Topcon TRC-NW8.
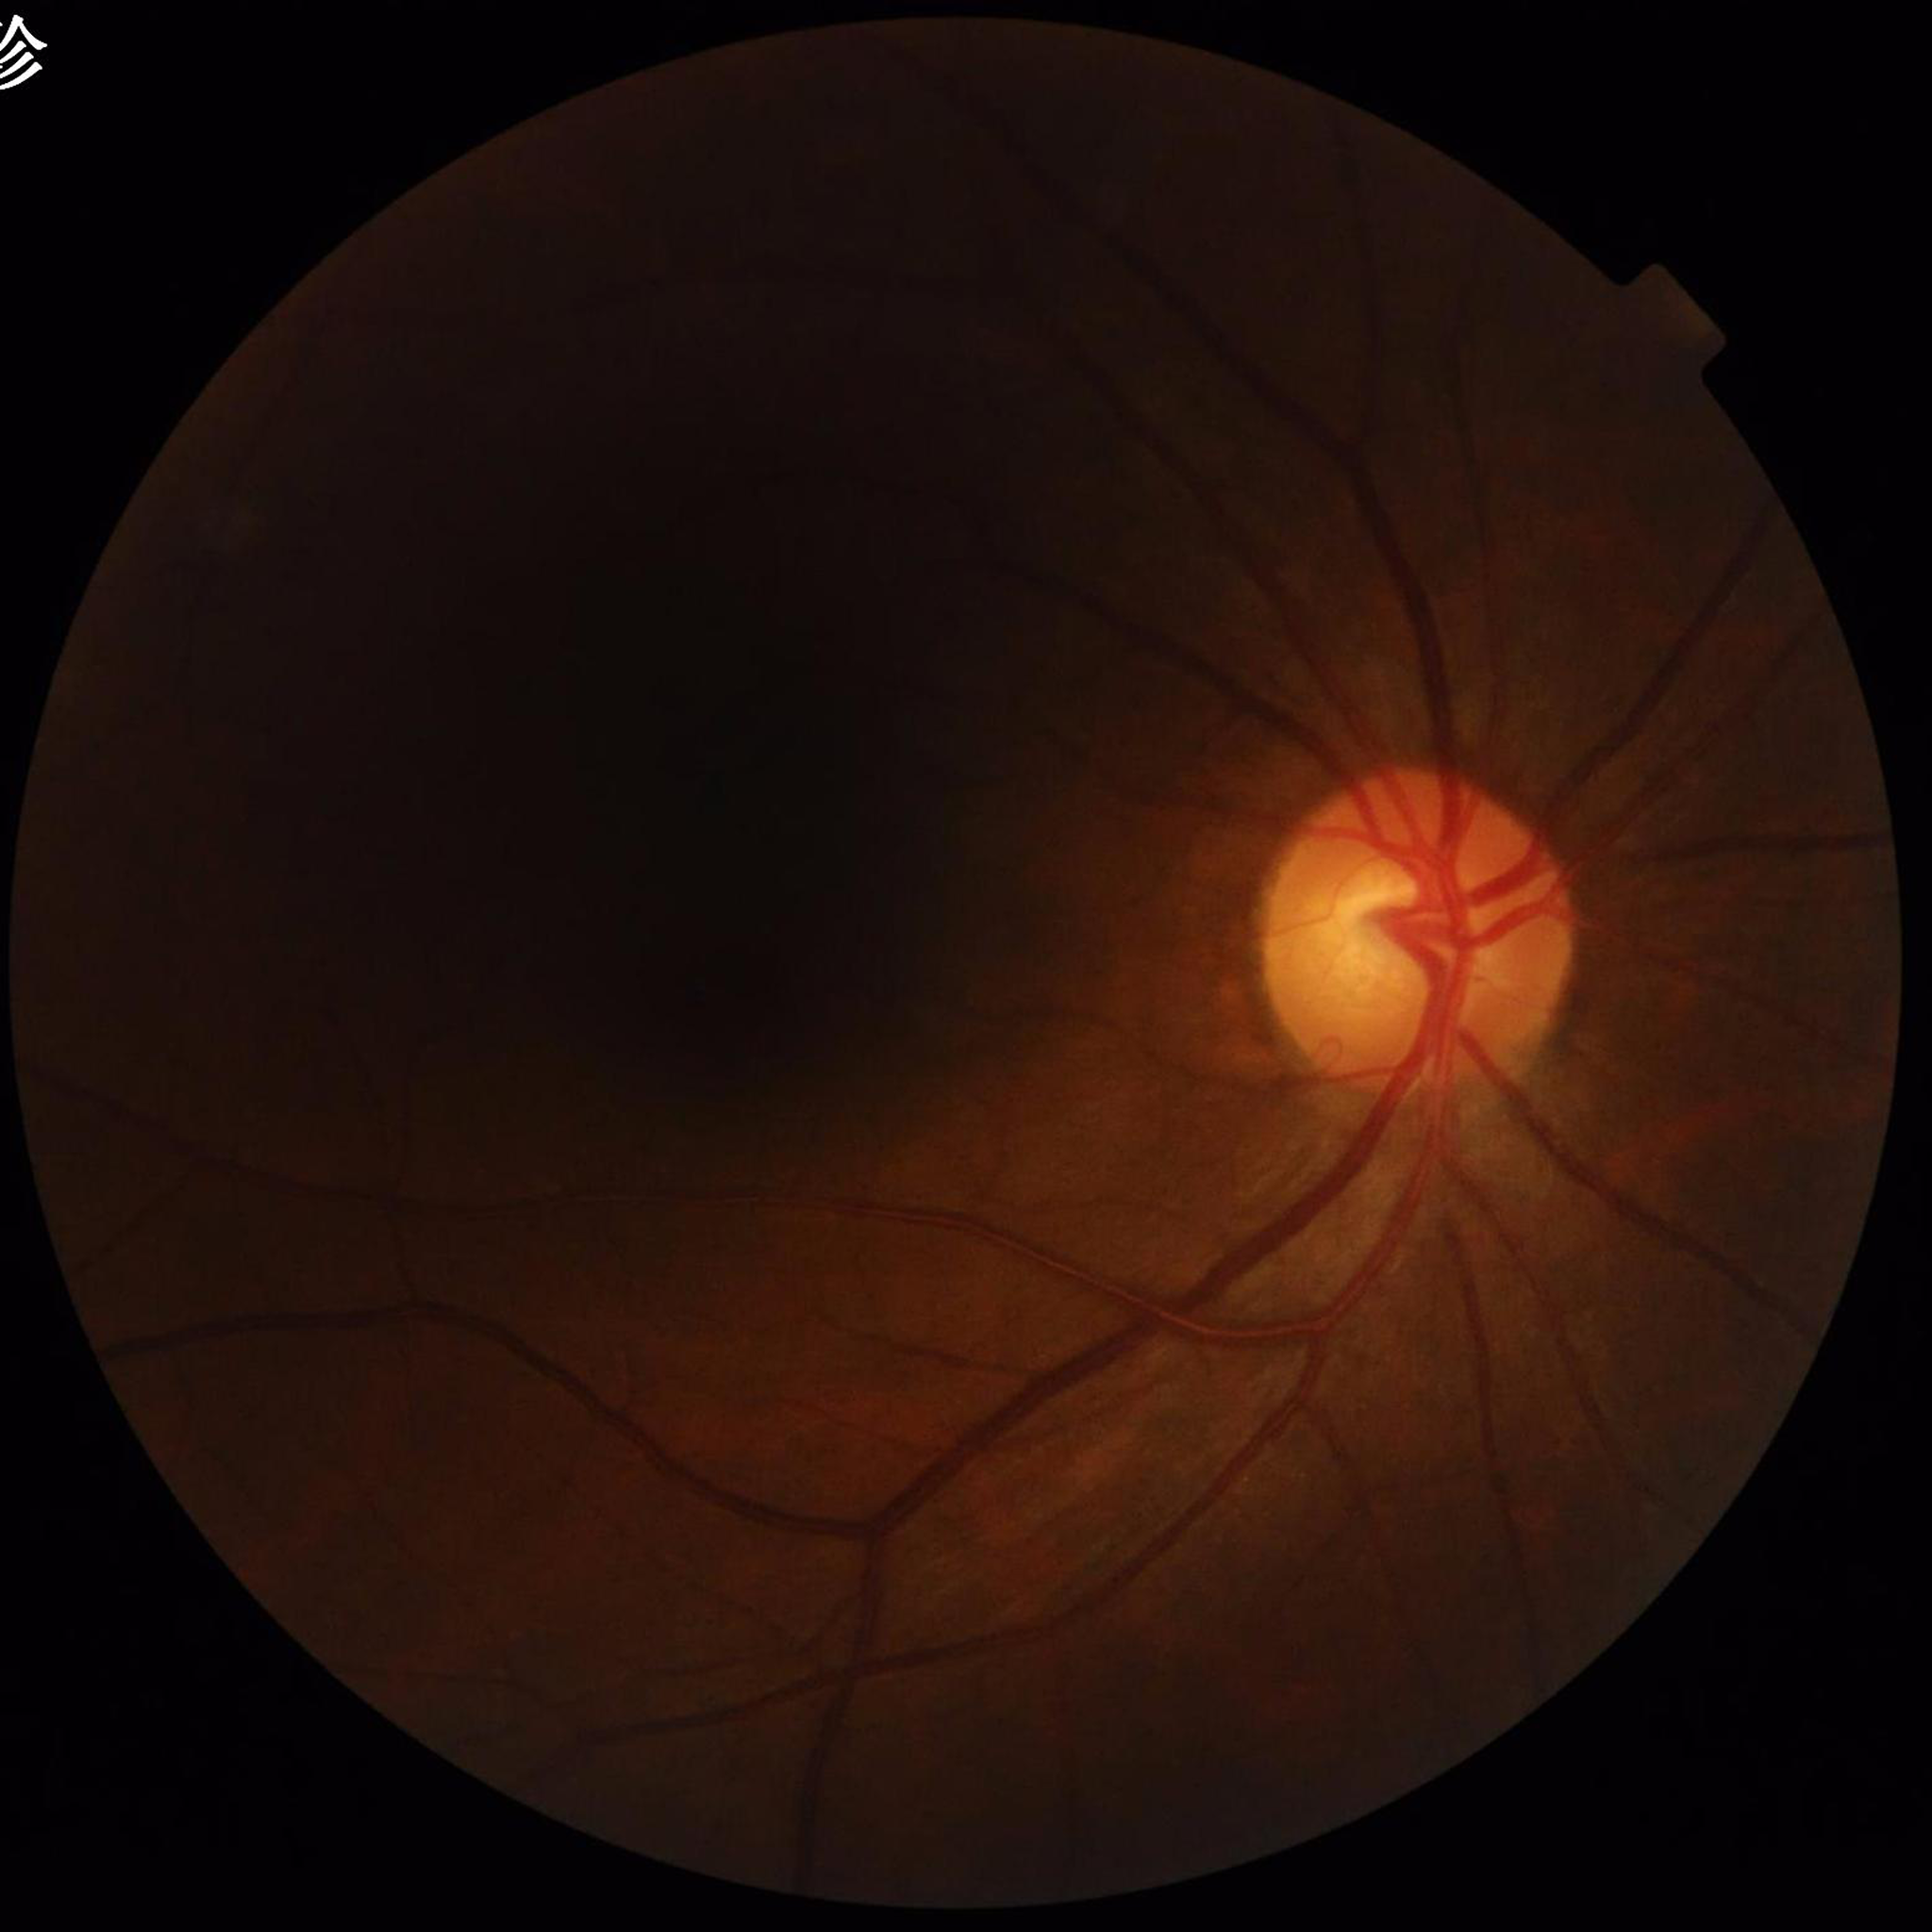
Color fundus photo. Patient diagnosed with glaucoma. Image quality: concerns include illumination/color distortion.